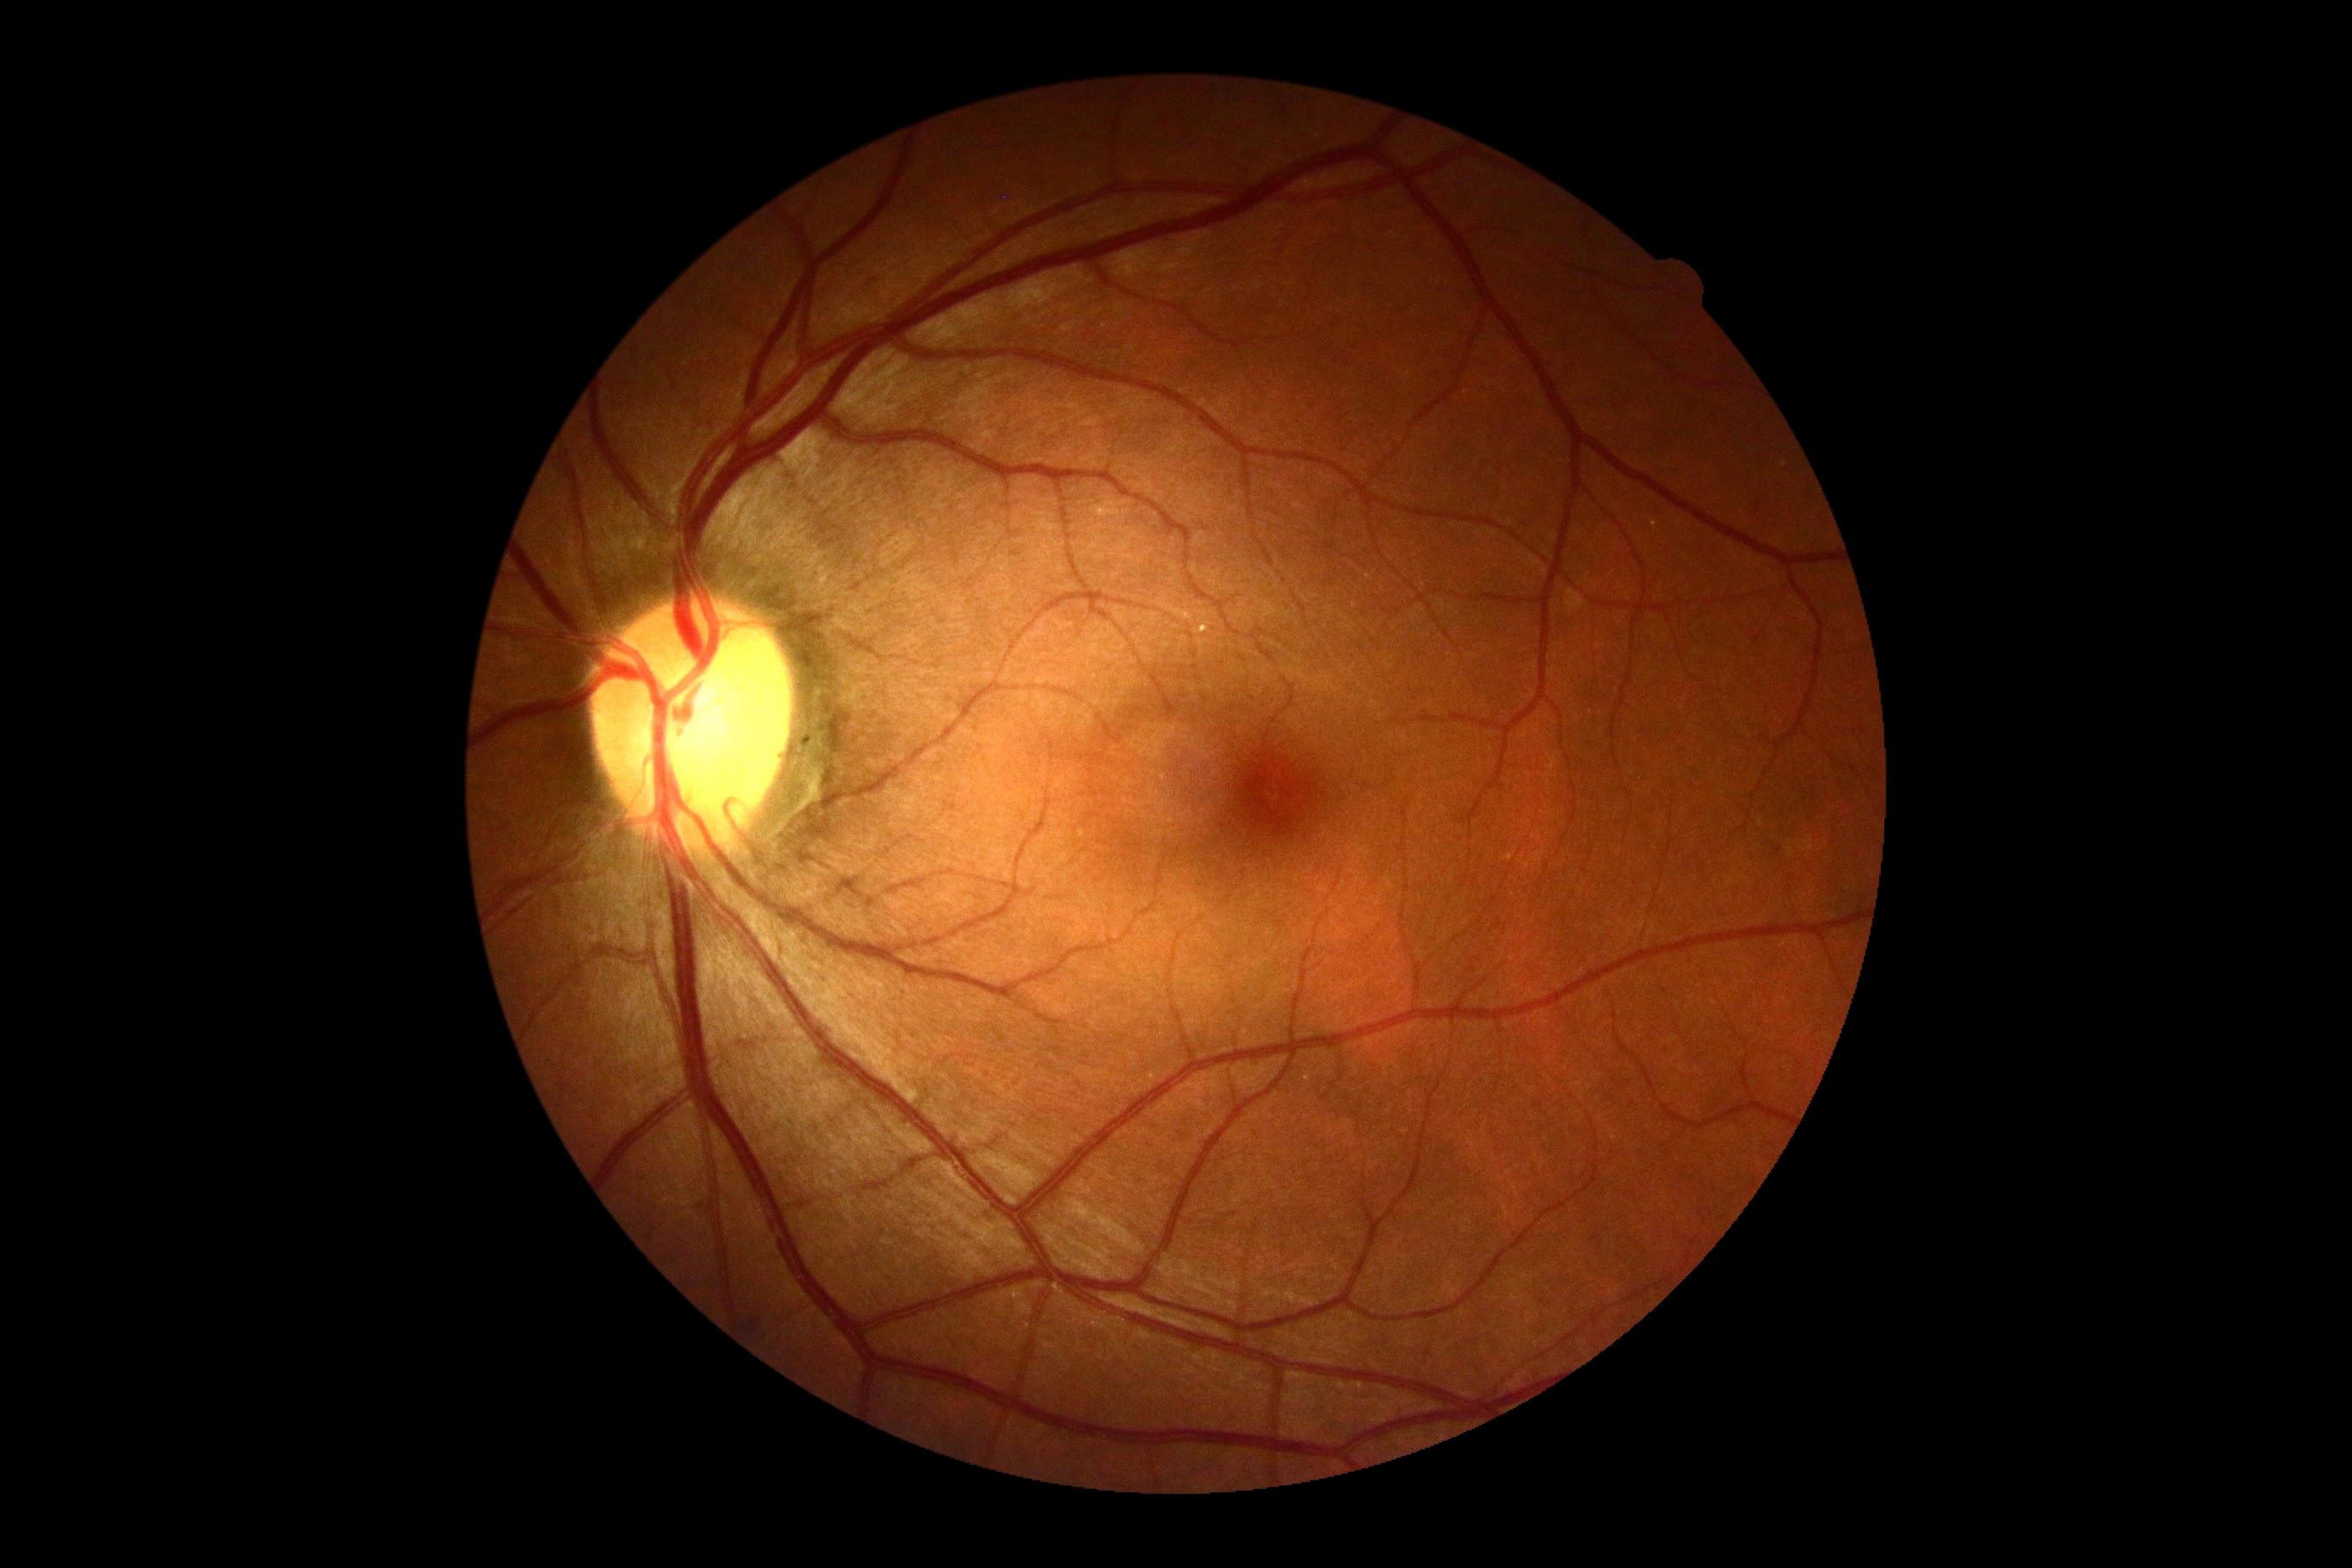

- retinopathy grade: 0 (no apparent retinopathy)
- DR impression: negative for DR